45° field of view
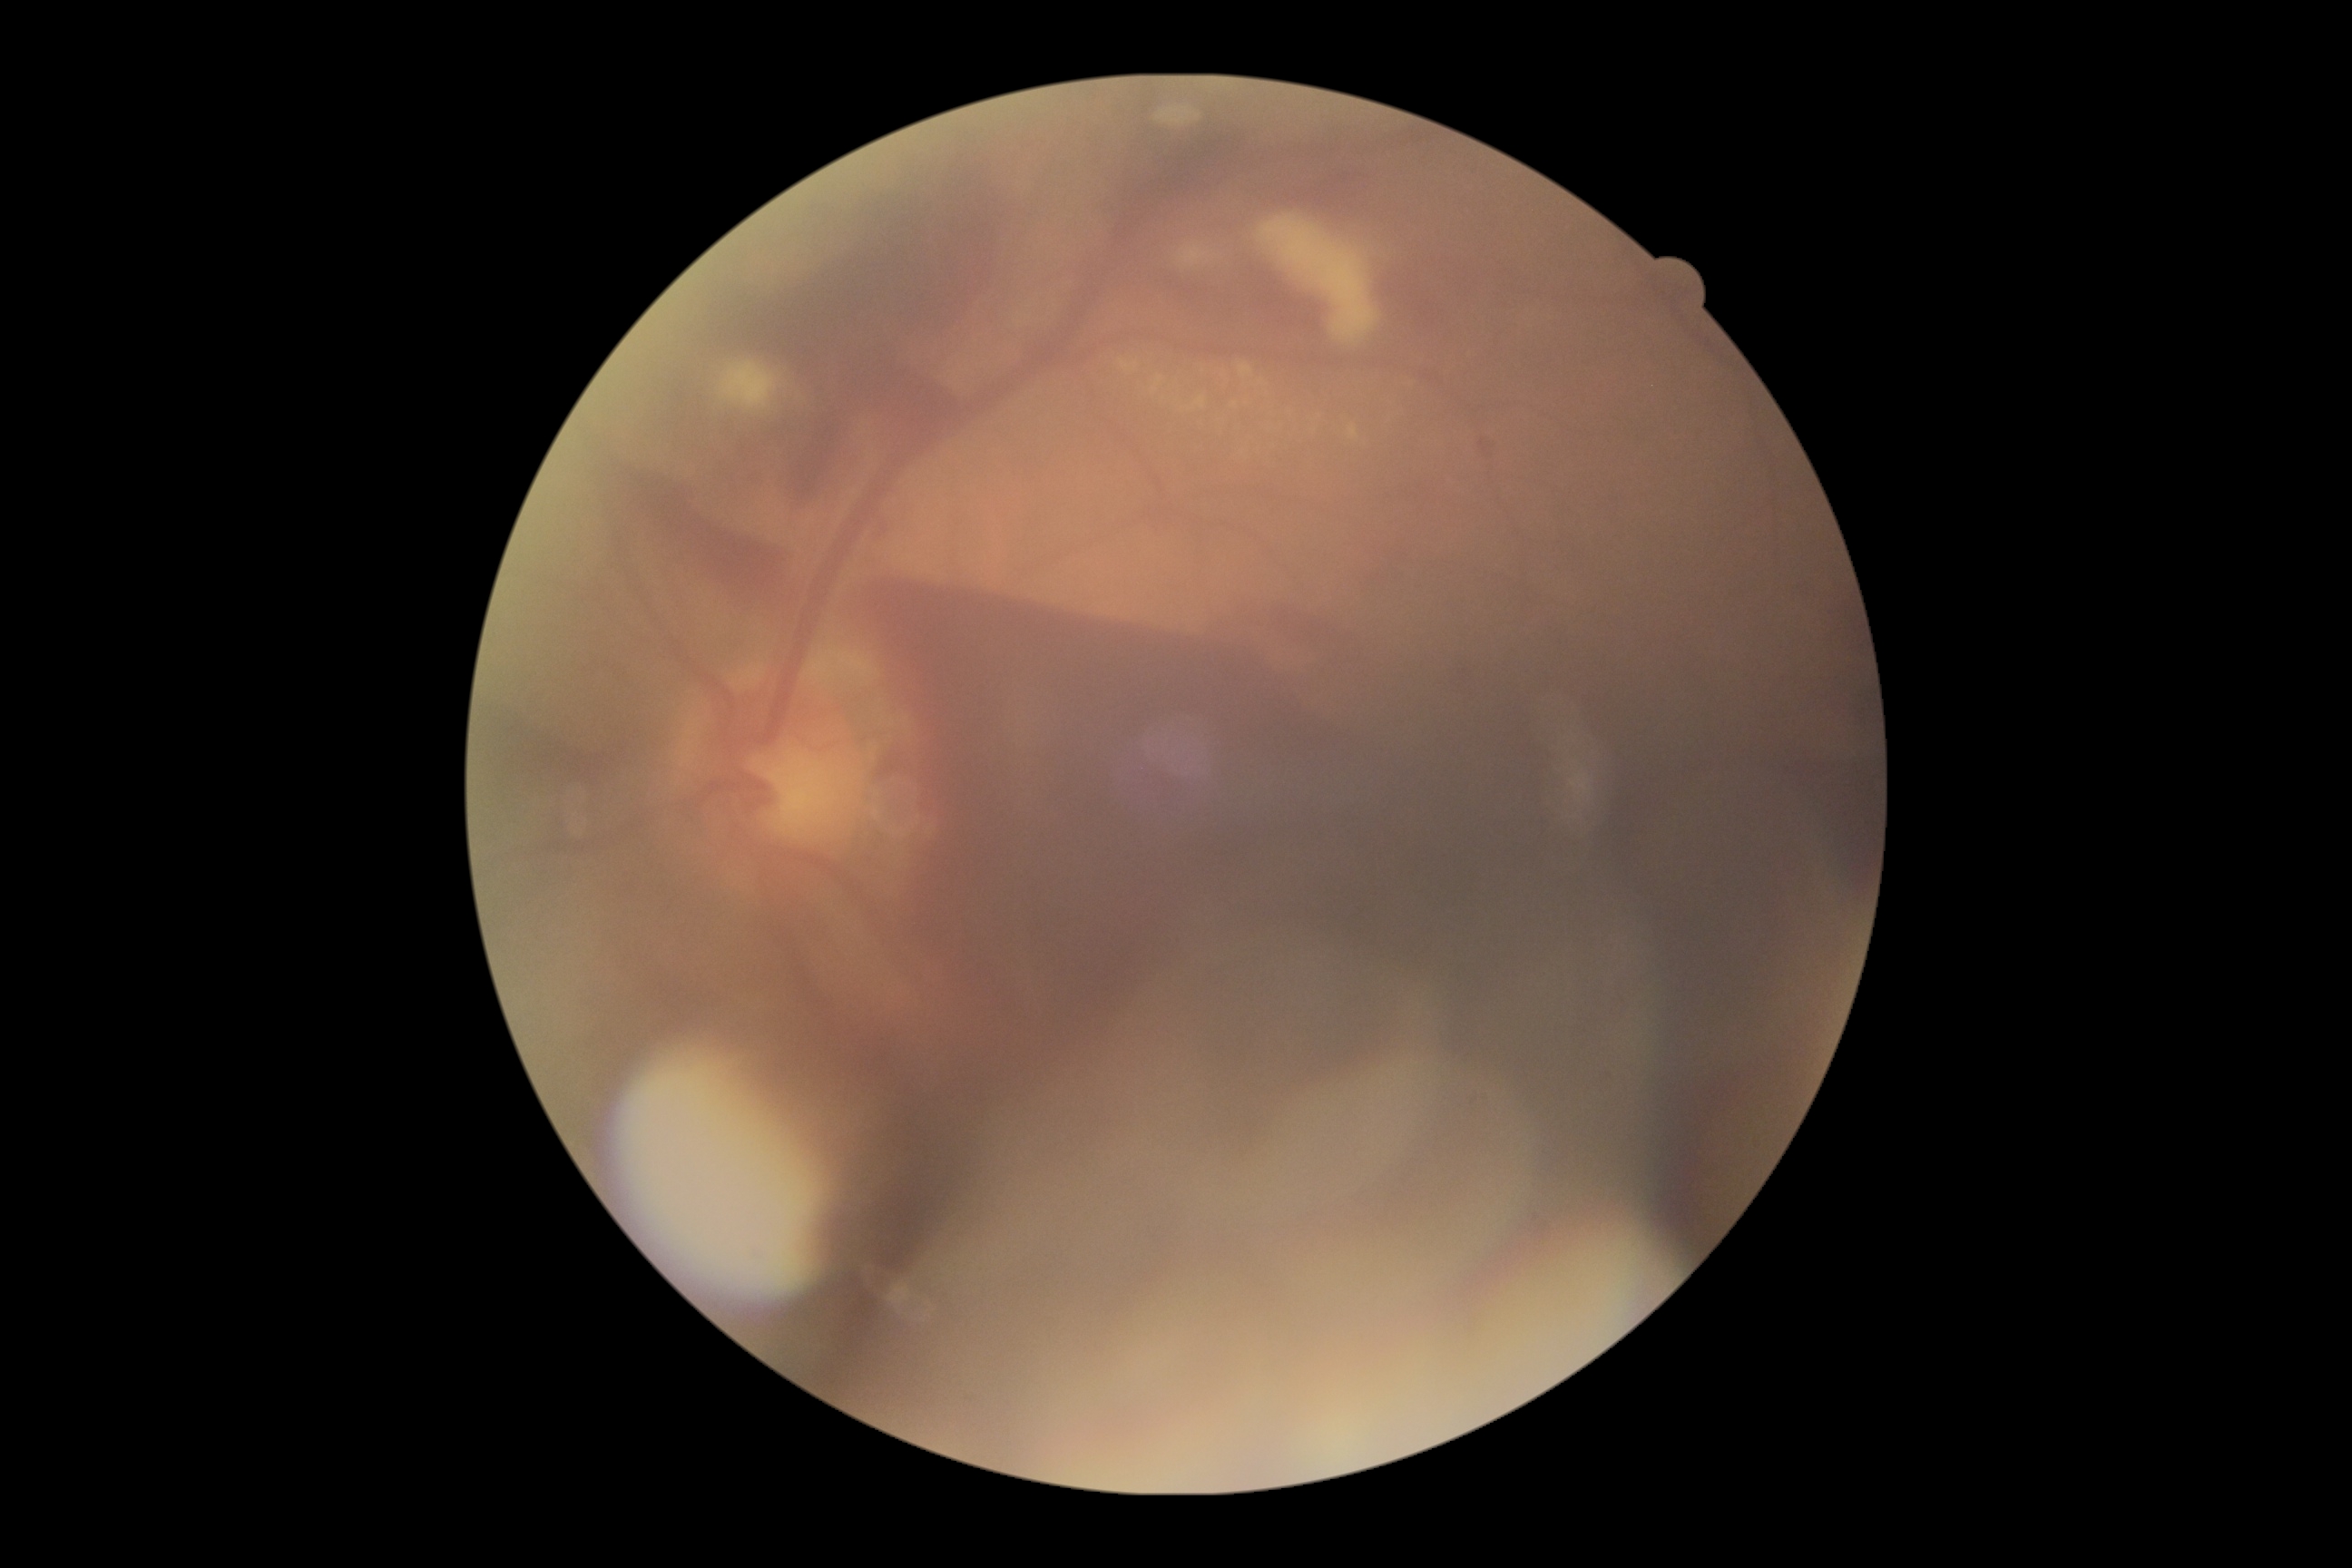
* diabetic retinopathy: 4